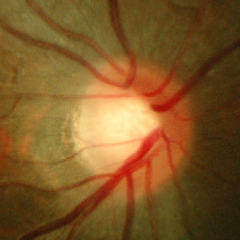 Optic disc photograph demonstrating no evidence of glaucoma.